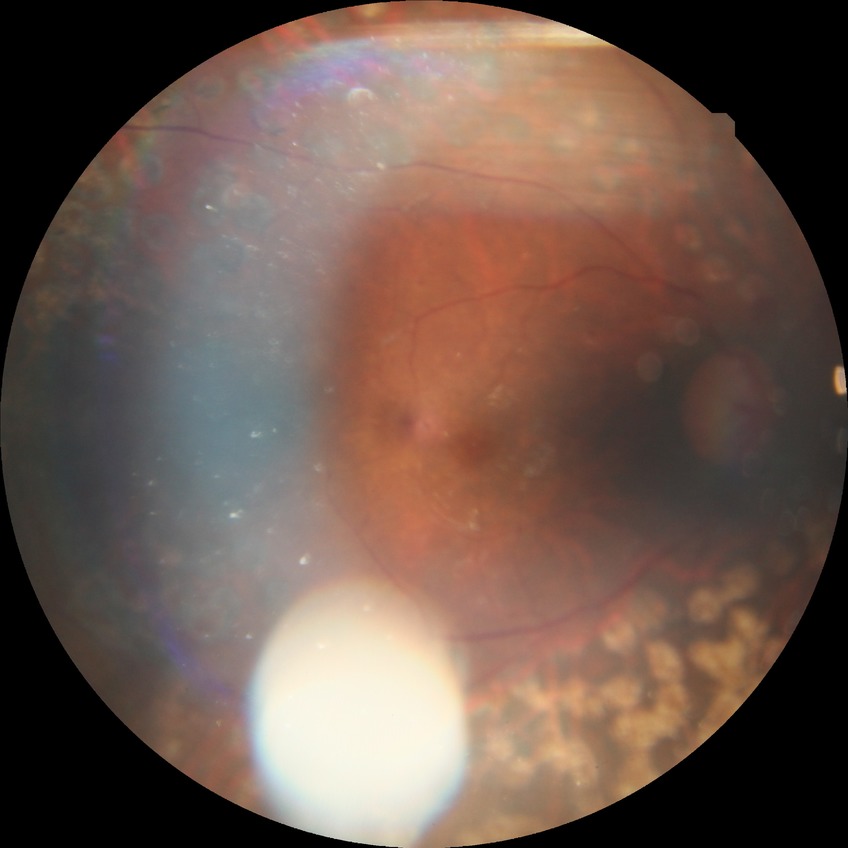 Diabetic retinopathy stage is proliferative diabetic retinopathy.